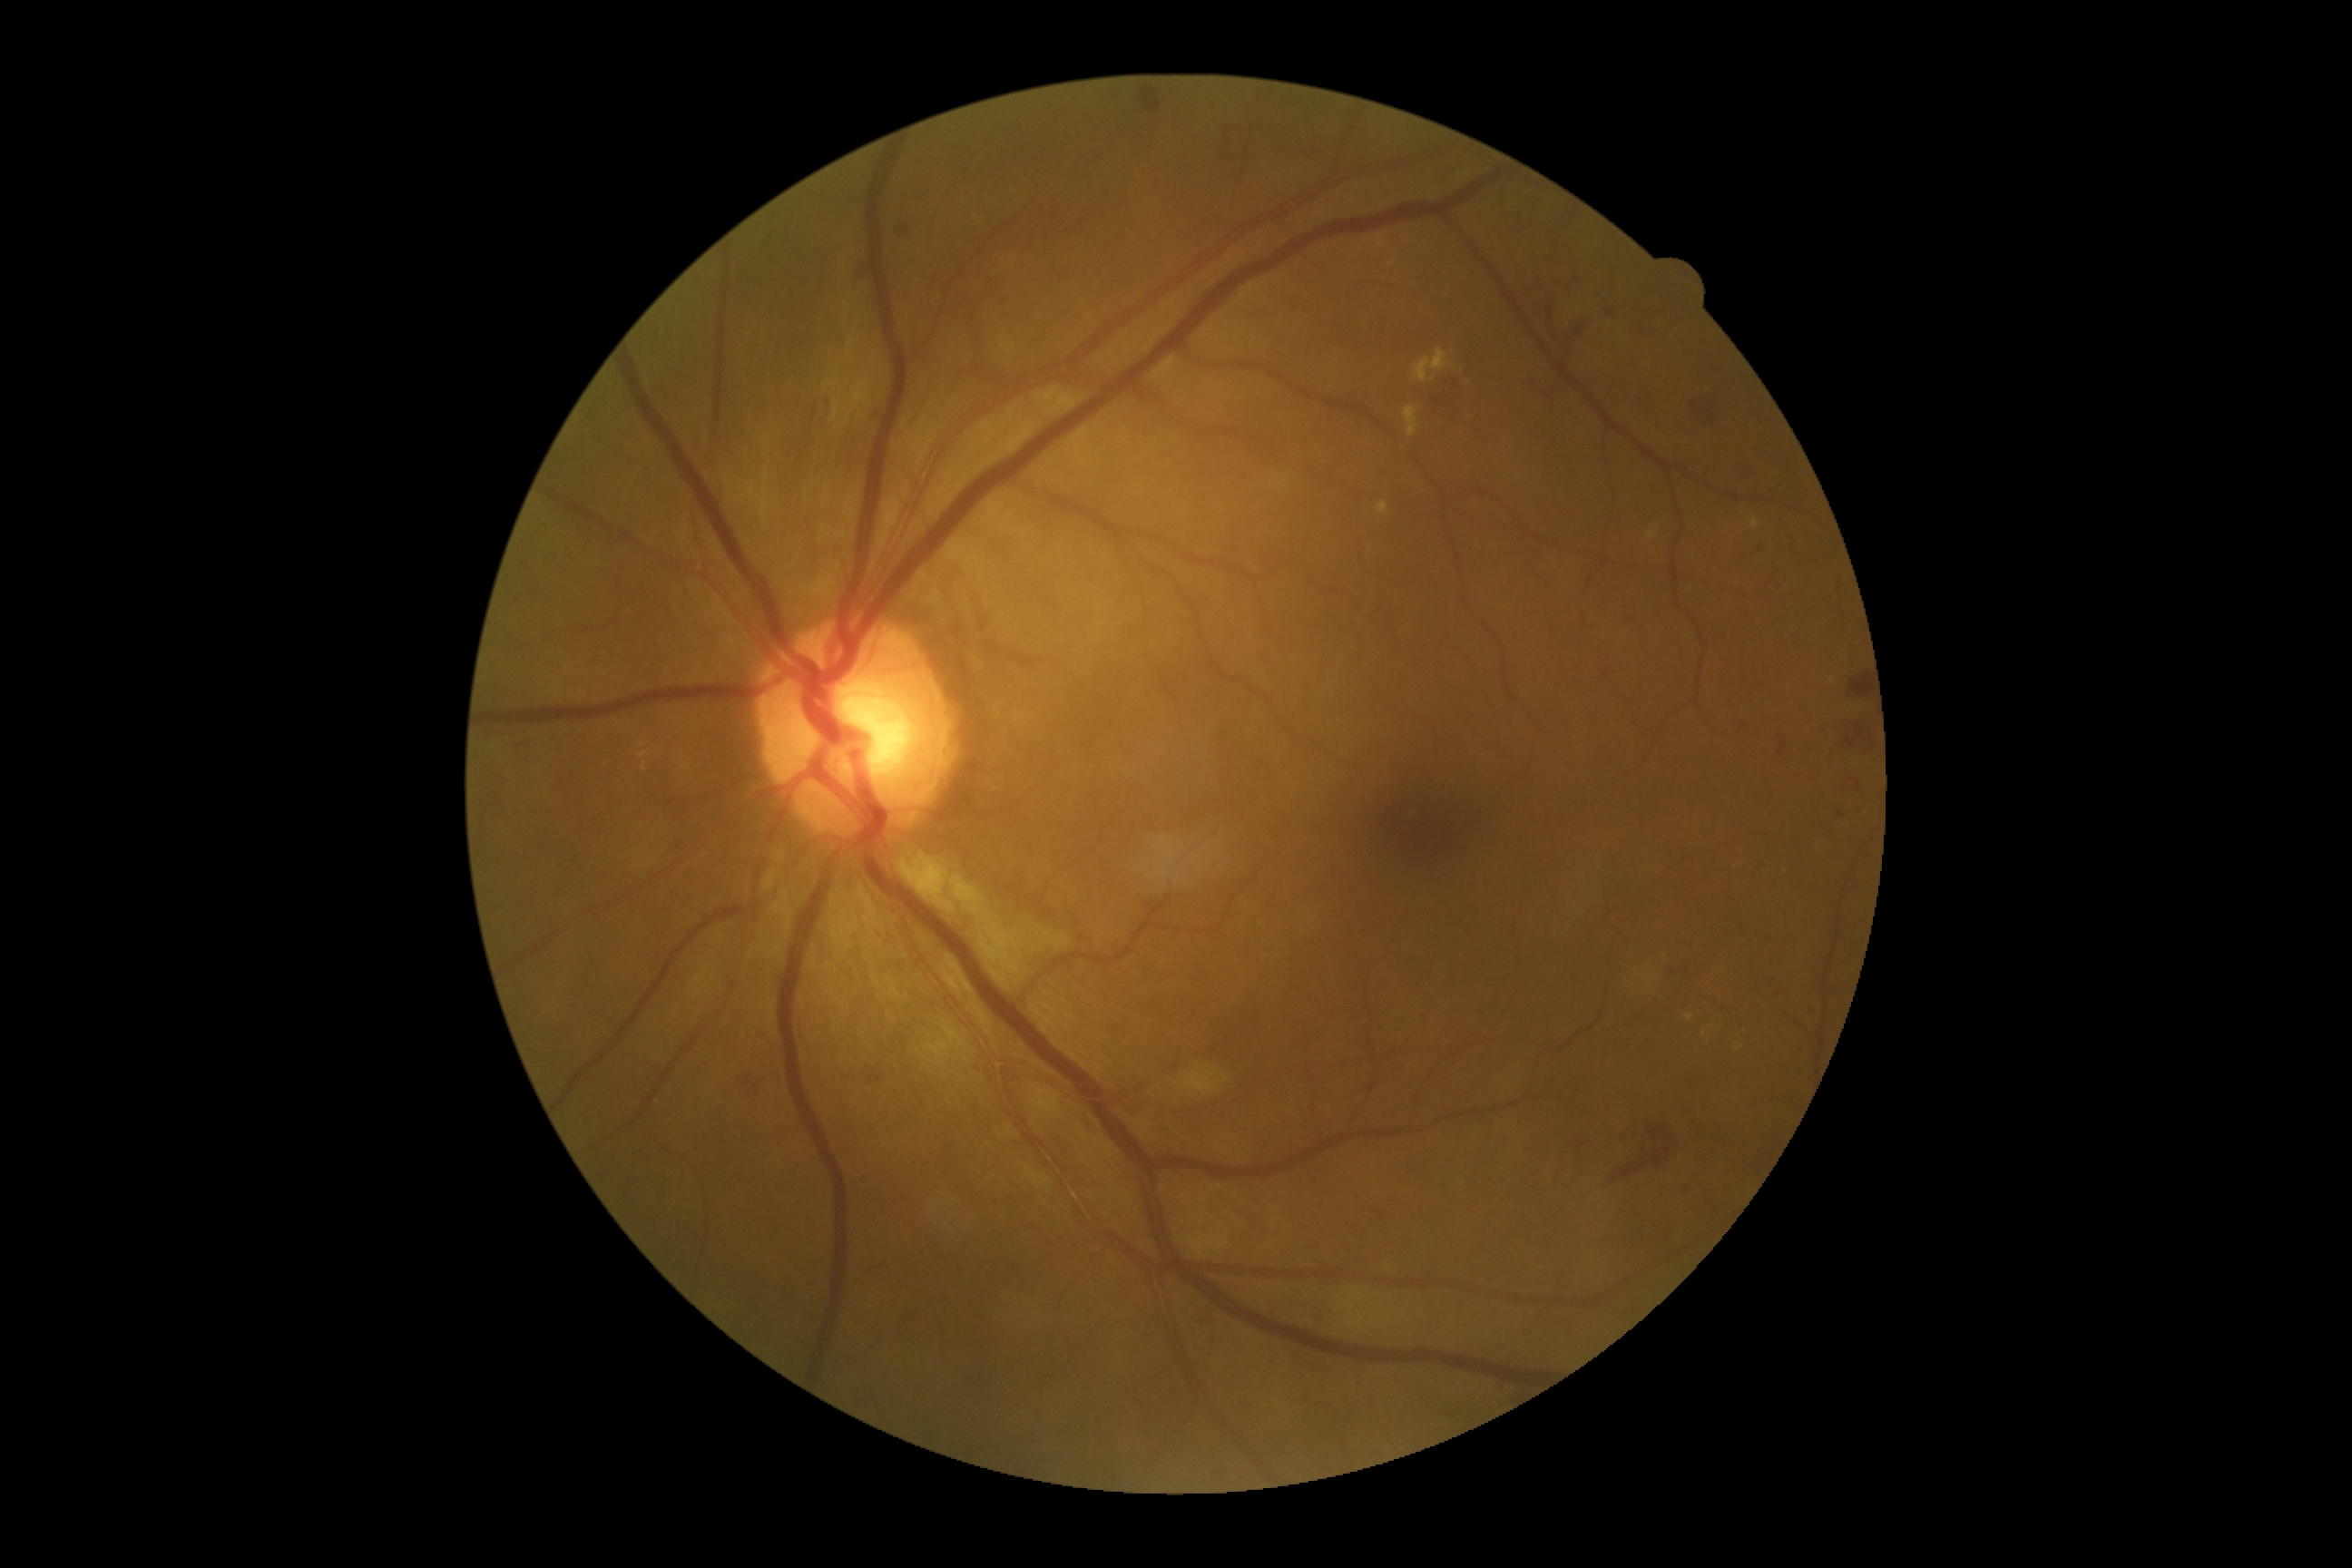
Findings:
– DR grade — 3